2352x1568px.
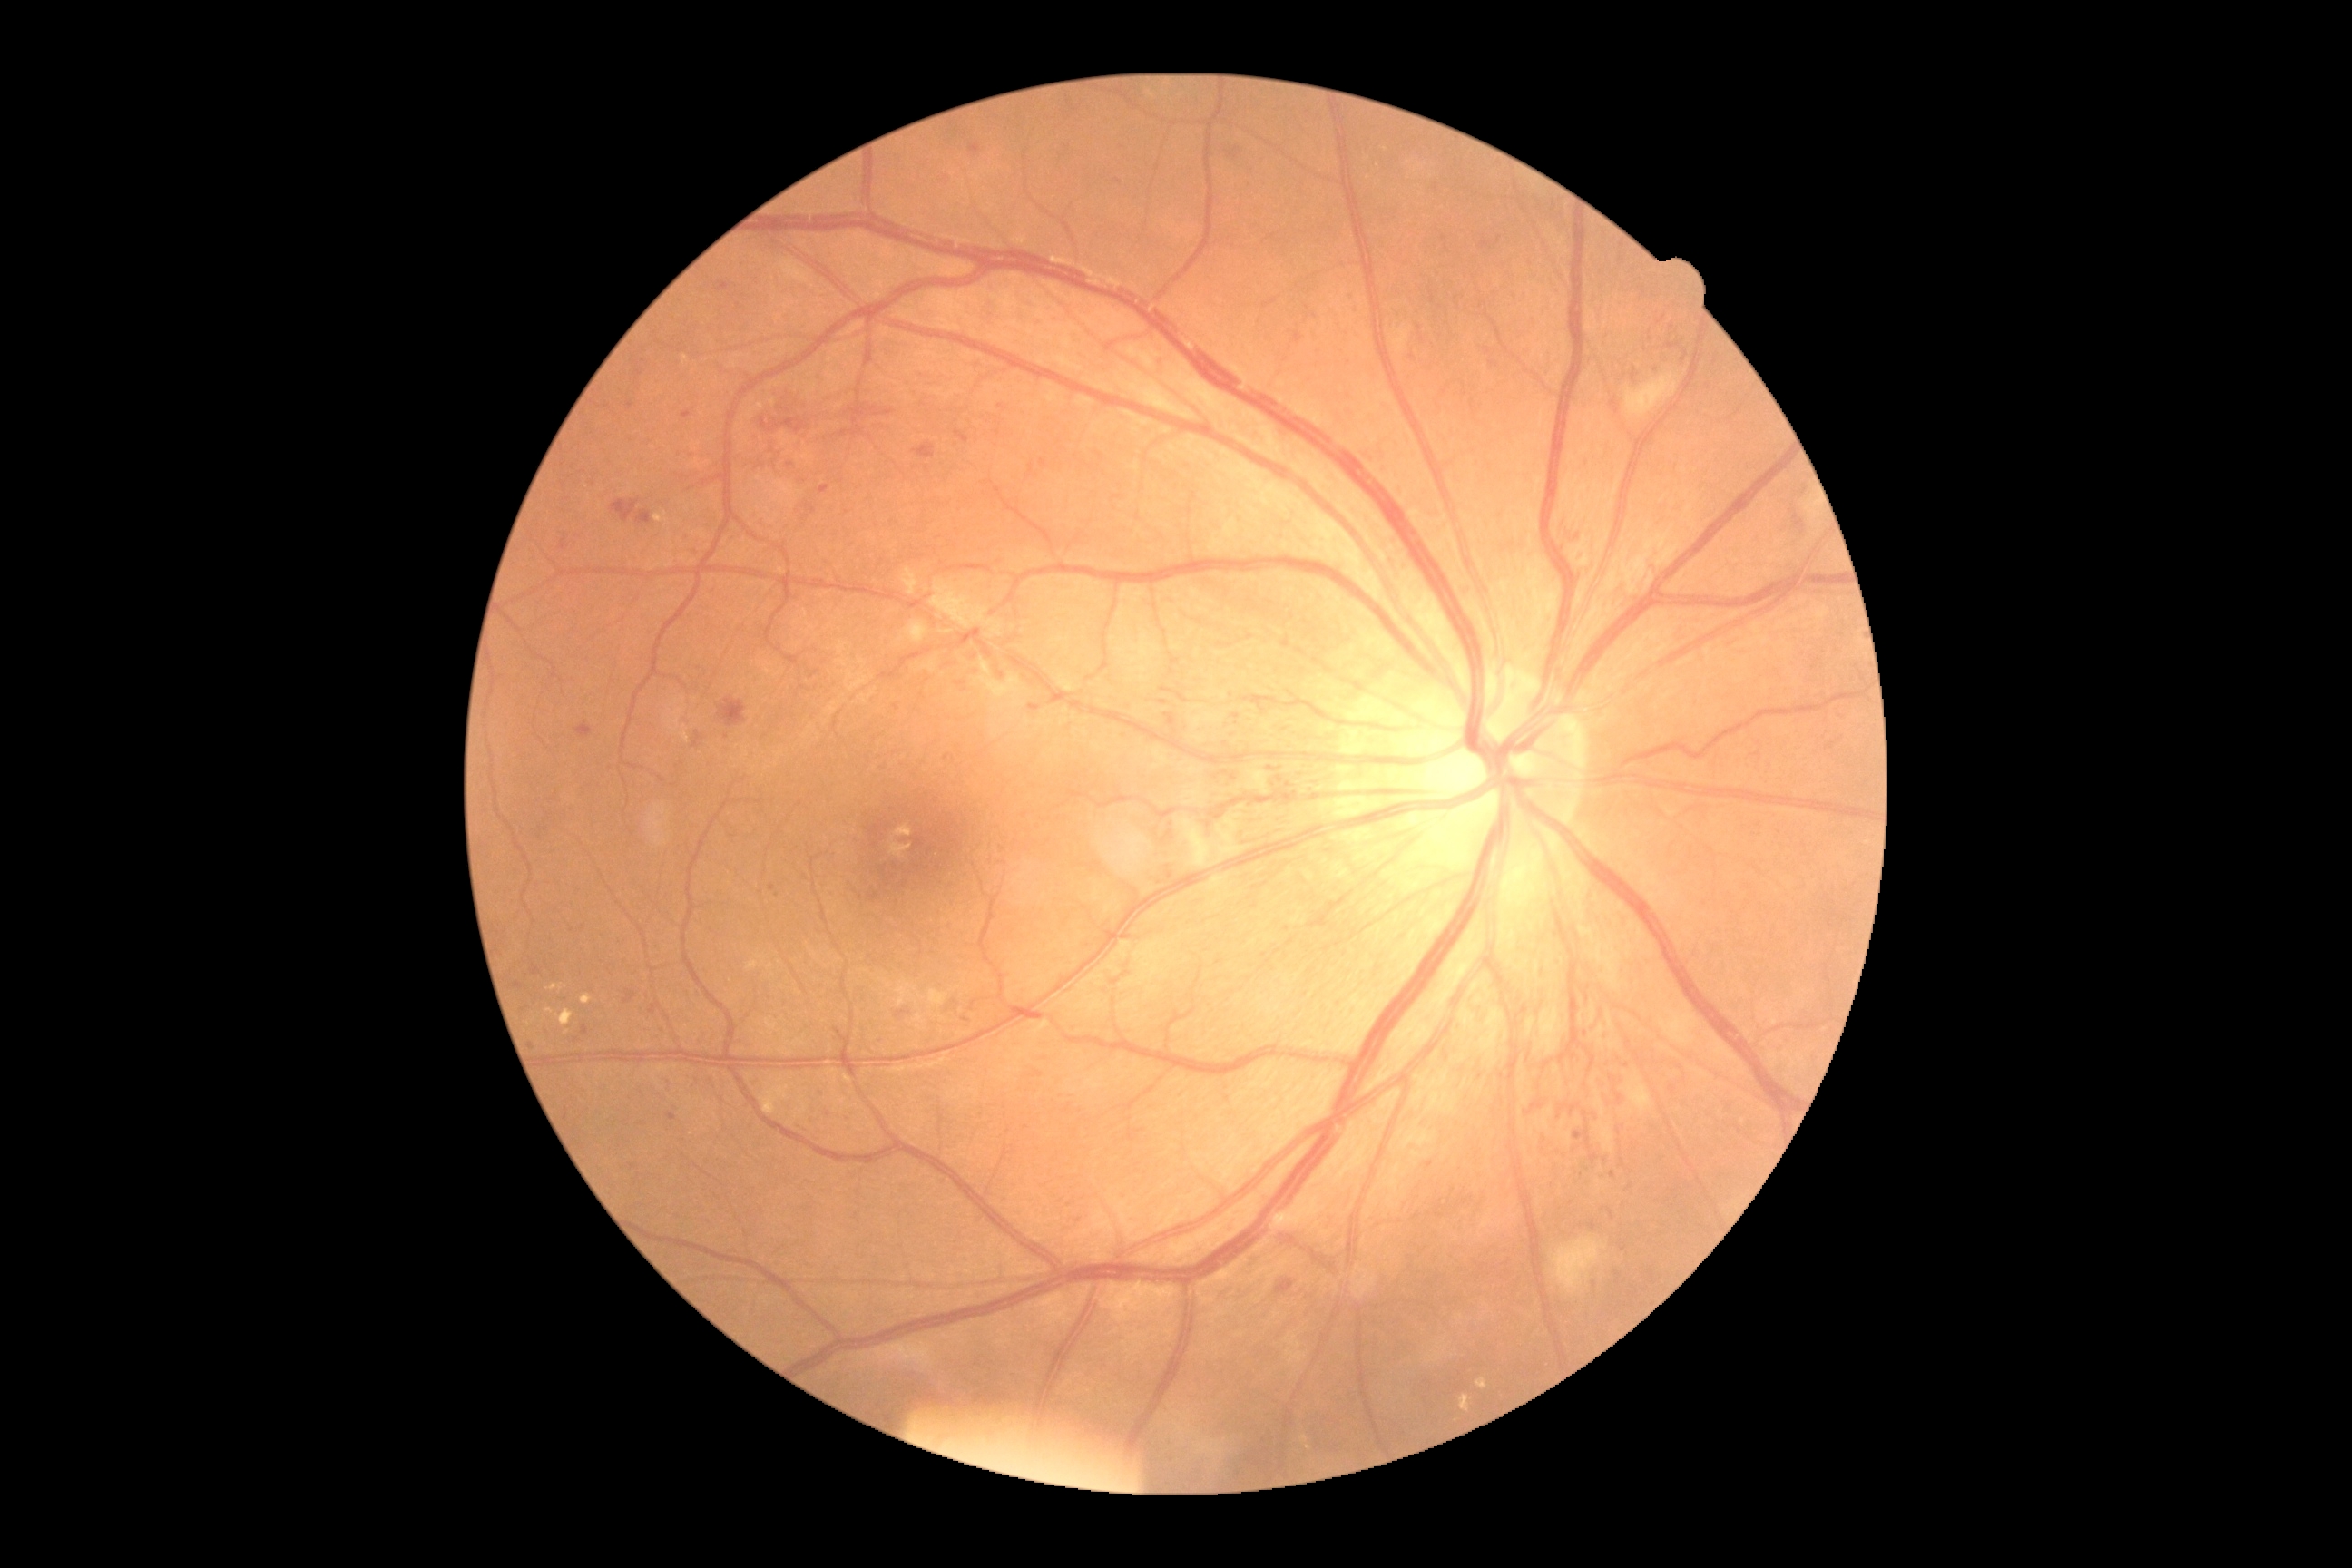
Diabetic retinopathy severity is 3/4 — more than 20 intraretinal hemorrhages in each of 4 quadrants, definite venous beading in 2 or more quadrants, or prominent intraretinal microvascular abnormalities in 1 or more quadrants, with no signs of proliferative retinopathy
Lesions identified (partial list):
hemorrhages (partial) = (1525, 1102, 1544, 1115); (1571, 525, 1580, 544); (694, 732, 701, 747); (1284, 783, 1295, 789); (718, 698, 747, 729); (560, 538, 569, 551); (582, 1026, 589, 1035); (1277, 1280, 1295, 1295); (1159, 700, 1168, 705); (1609, 1066, 1625, 1106); (1164, 714, 1177, 727); (1585, 994, 1589, 1003)
Hemorrhages (small, approximate centers) near {"x": 1488, "y": 351}; {"x": 947, "y": 757}
soft exudates = (1553, 1237, 1607, 1295); (905, 622, 928, 645); (1181, 814, 1246, 868); (1623, 1075, 1654, 1115); (1625, 375, 1678, 418)
hard exudates = (654, 513, 669, 524); (767, 1106, 772, 1117); (749, 404, 765, 420); (1460, 1395, 1471, 1413); (580, 994, 593, 1004); (683, 355, 689, 364); (1476, 1378, 1487, 1389); (556, 1010, 574, 1026); (1300, 1435, 1309, 1442); (547, 985, 564, 992)
Hard exudates (small, approximate centers) near {"x": 550, "y": 1012}; {"x": 567, "y": 1032}; {"x": 1308, "y": 1448}; {"x": 773, "y": 403}
microaneurysms (partial) = (634, 369, 643, 380); (970, 144, 981, 155); (1611, 1171, 1616, 1179); (683, 411, 692, 420); (691, 451, 696, 460); (1349, 289, 1357, 299)
Microaneurysms (small, approximate centers) near {"x": 834, "y": 892}; {"x": 1002, "y": 408}; {"x": 1420, "y": 329}; {"x": 680, "y": 453}; {"x": 1009, "y": 1197}; {"x": 1585, "y": 1034}; {"x": 1578, "y": 538}; {"x": 758, "y": 435}; {"x": 727, "y": 738}; {"x": 875, "y": 739}; {"x": 1579, "y": 1134}